CFP: 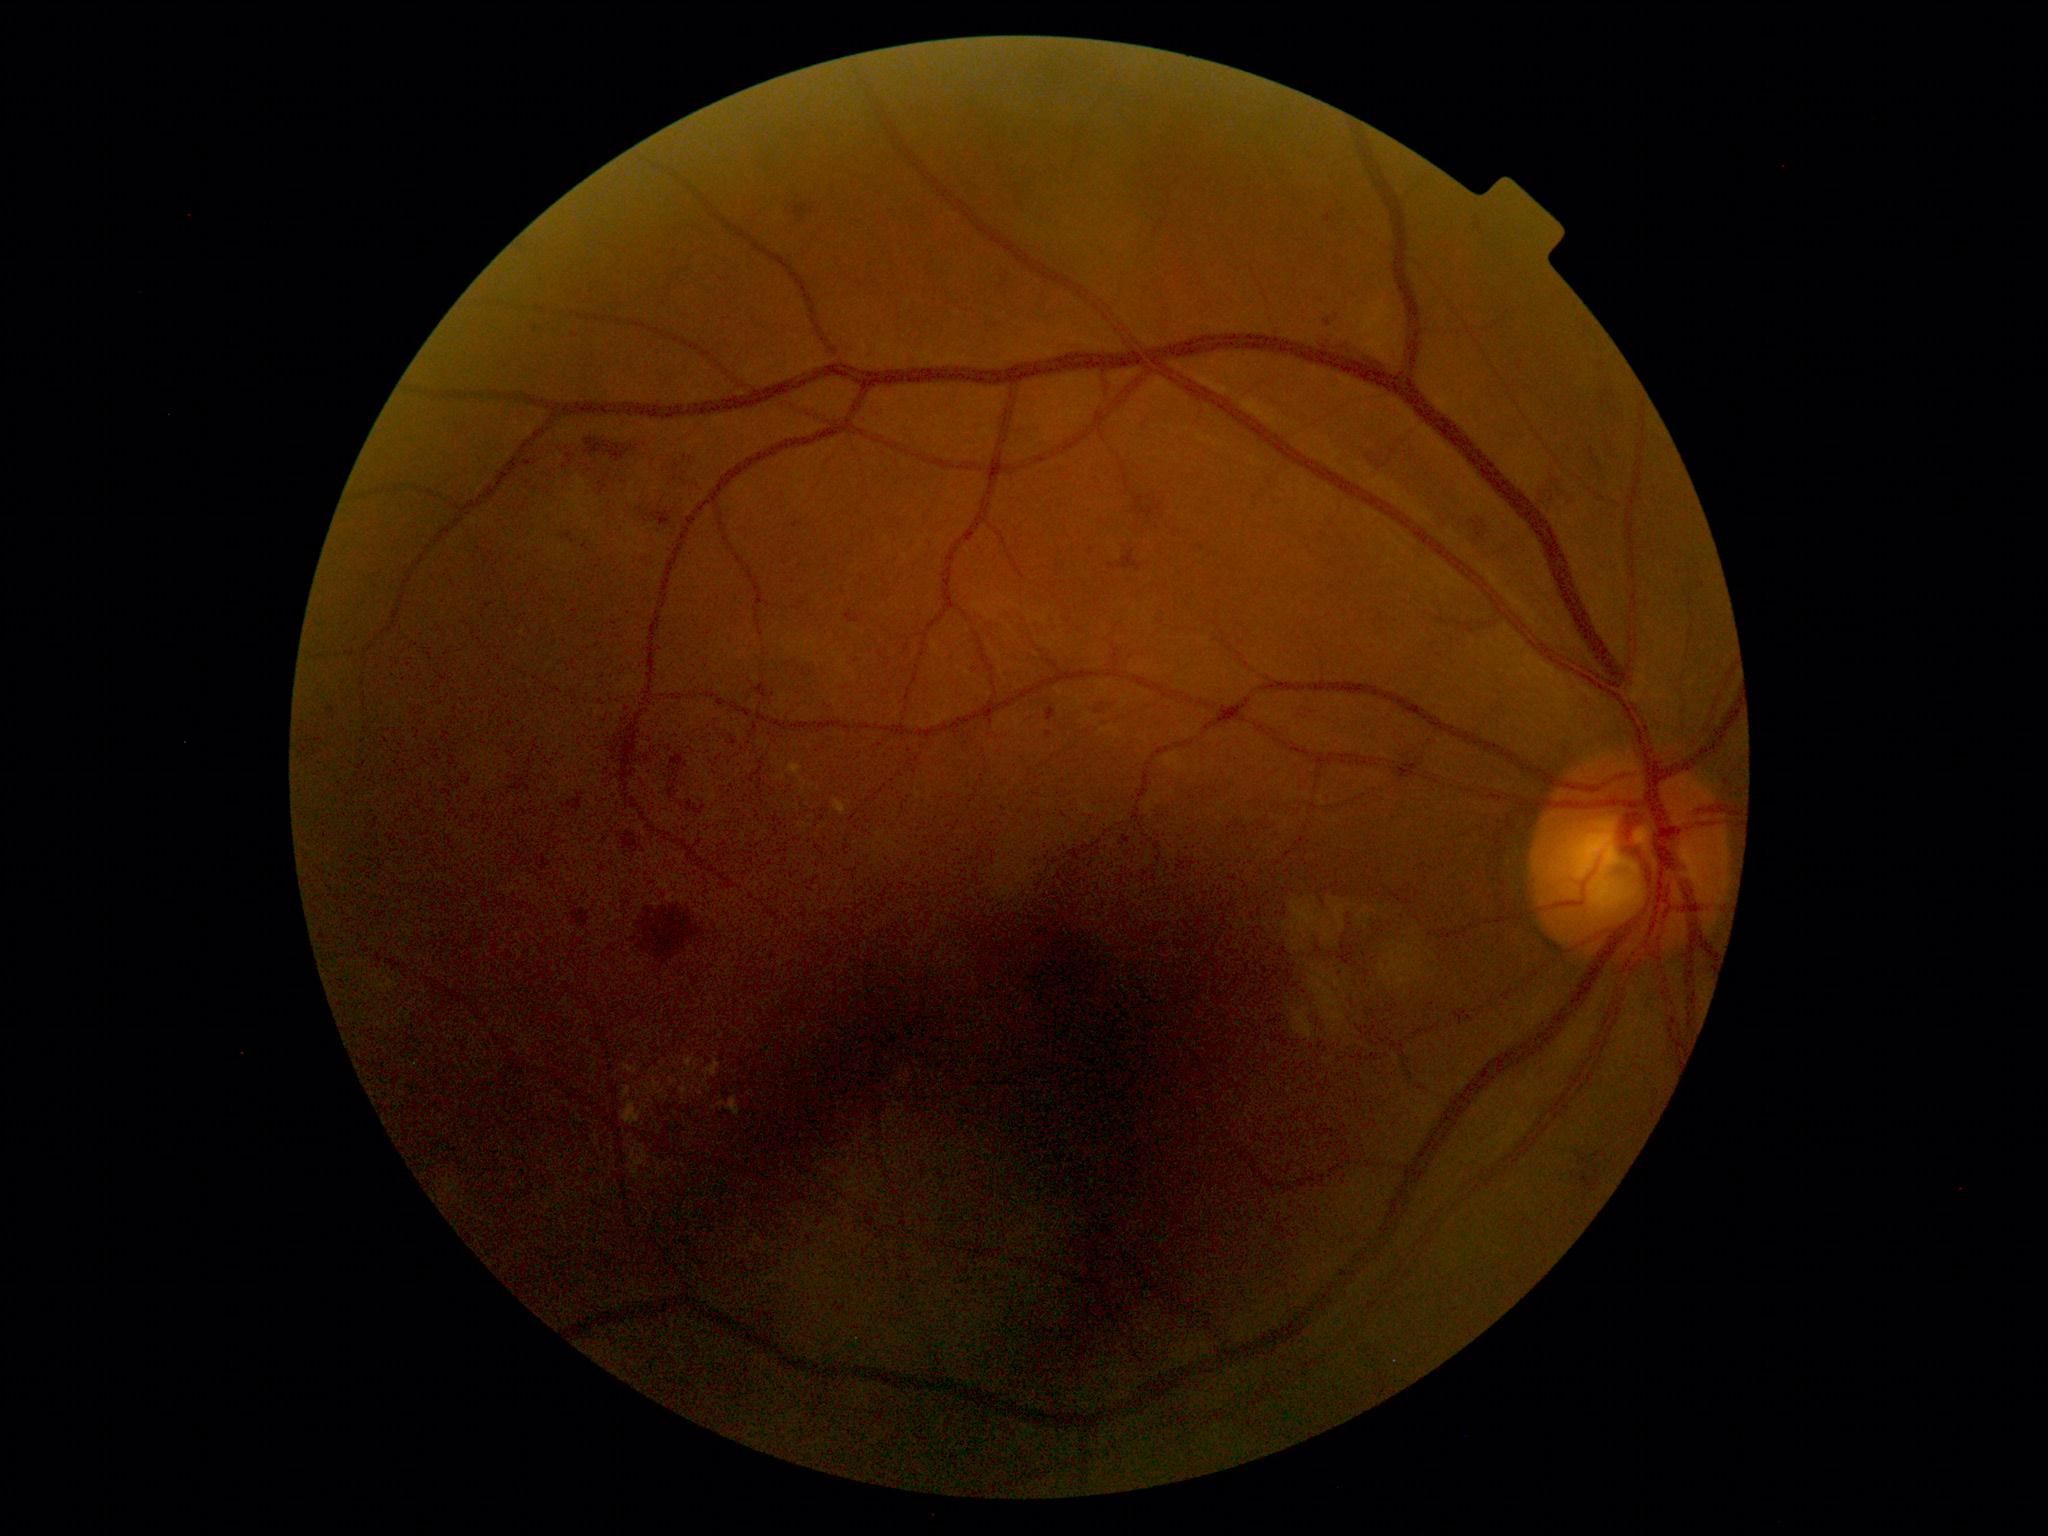
The retinopathy is classified as non-proliferative diabetic retinopathy.
DR: grade 2.